Modified Davis grading
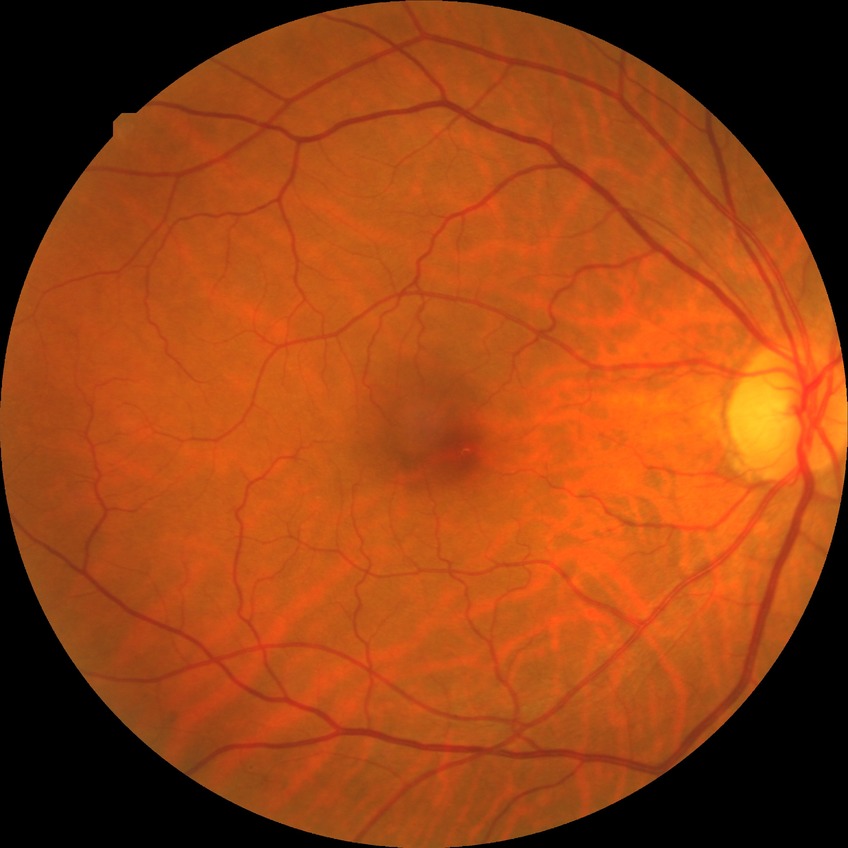 Davis grading: simple diabetic retinopathy.